Macula at the center of the field. Fundus photo. Topcon TRC-NW8
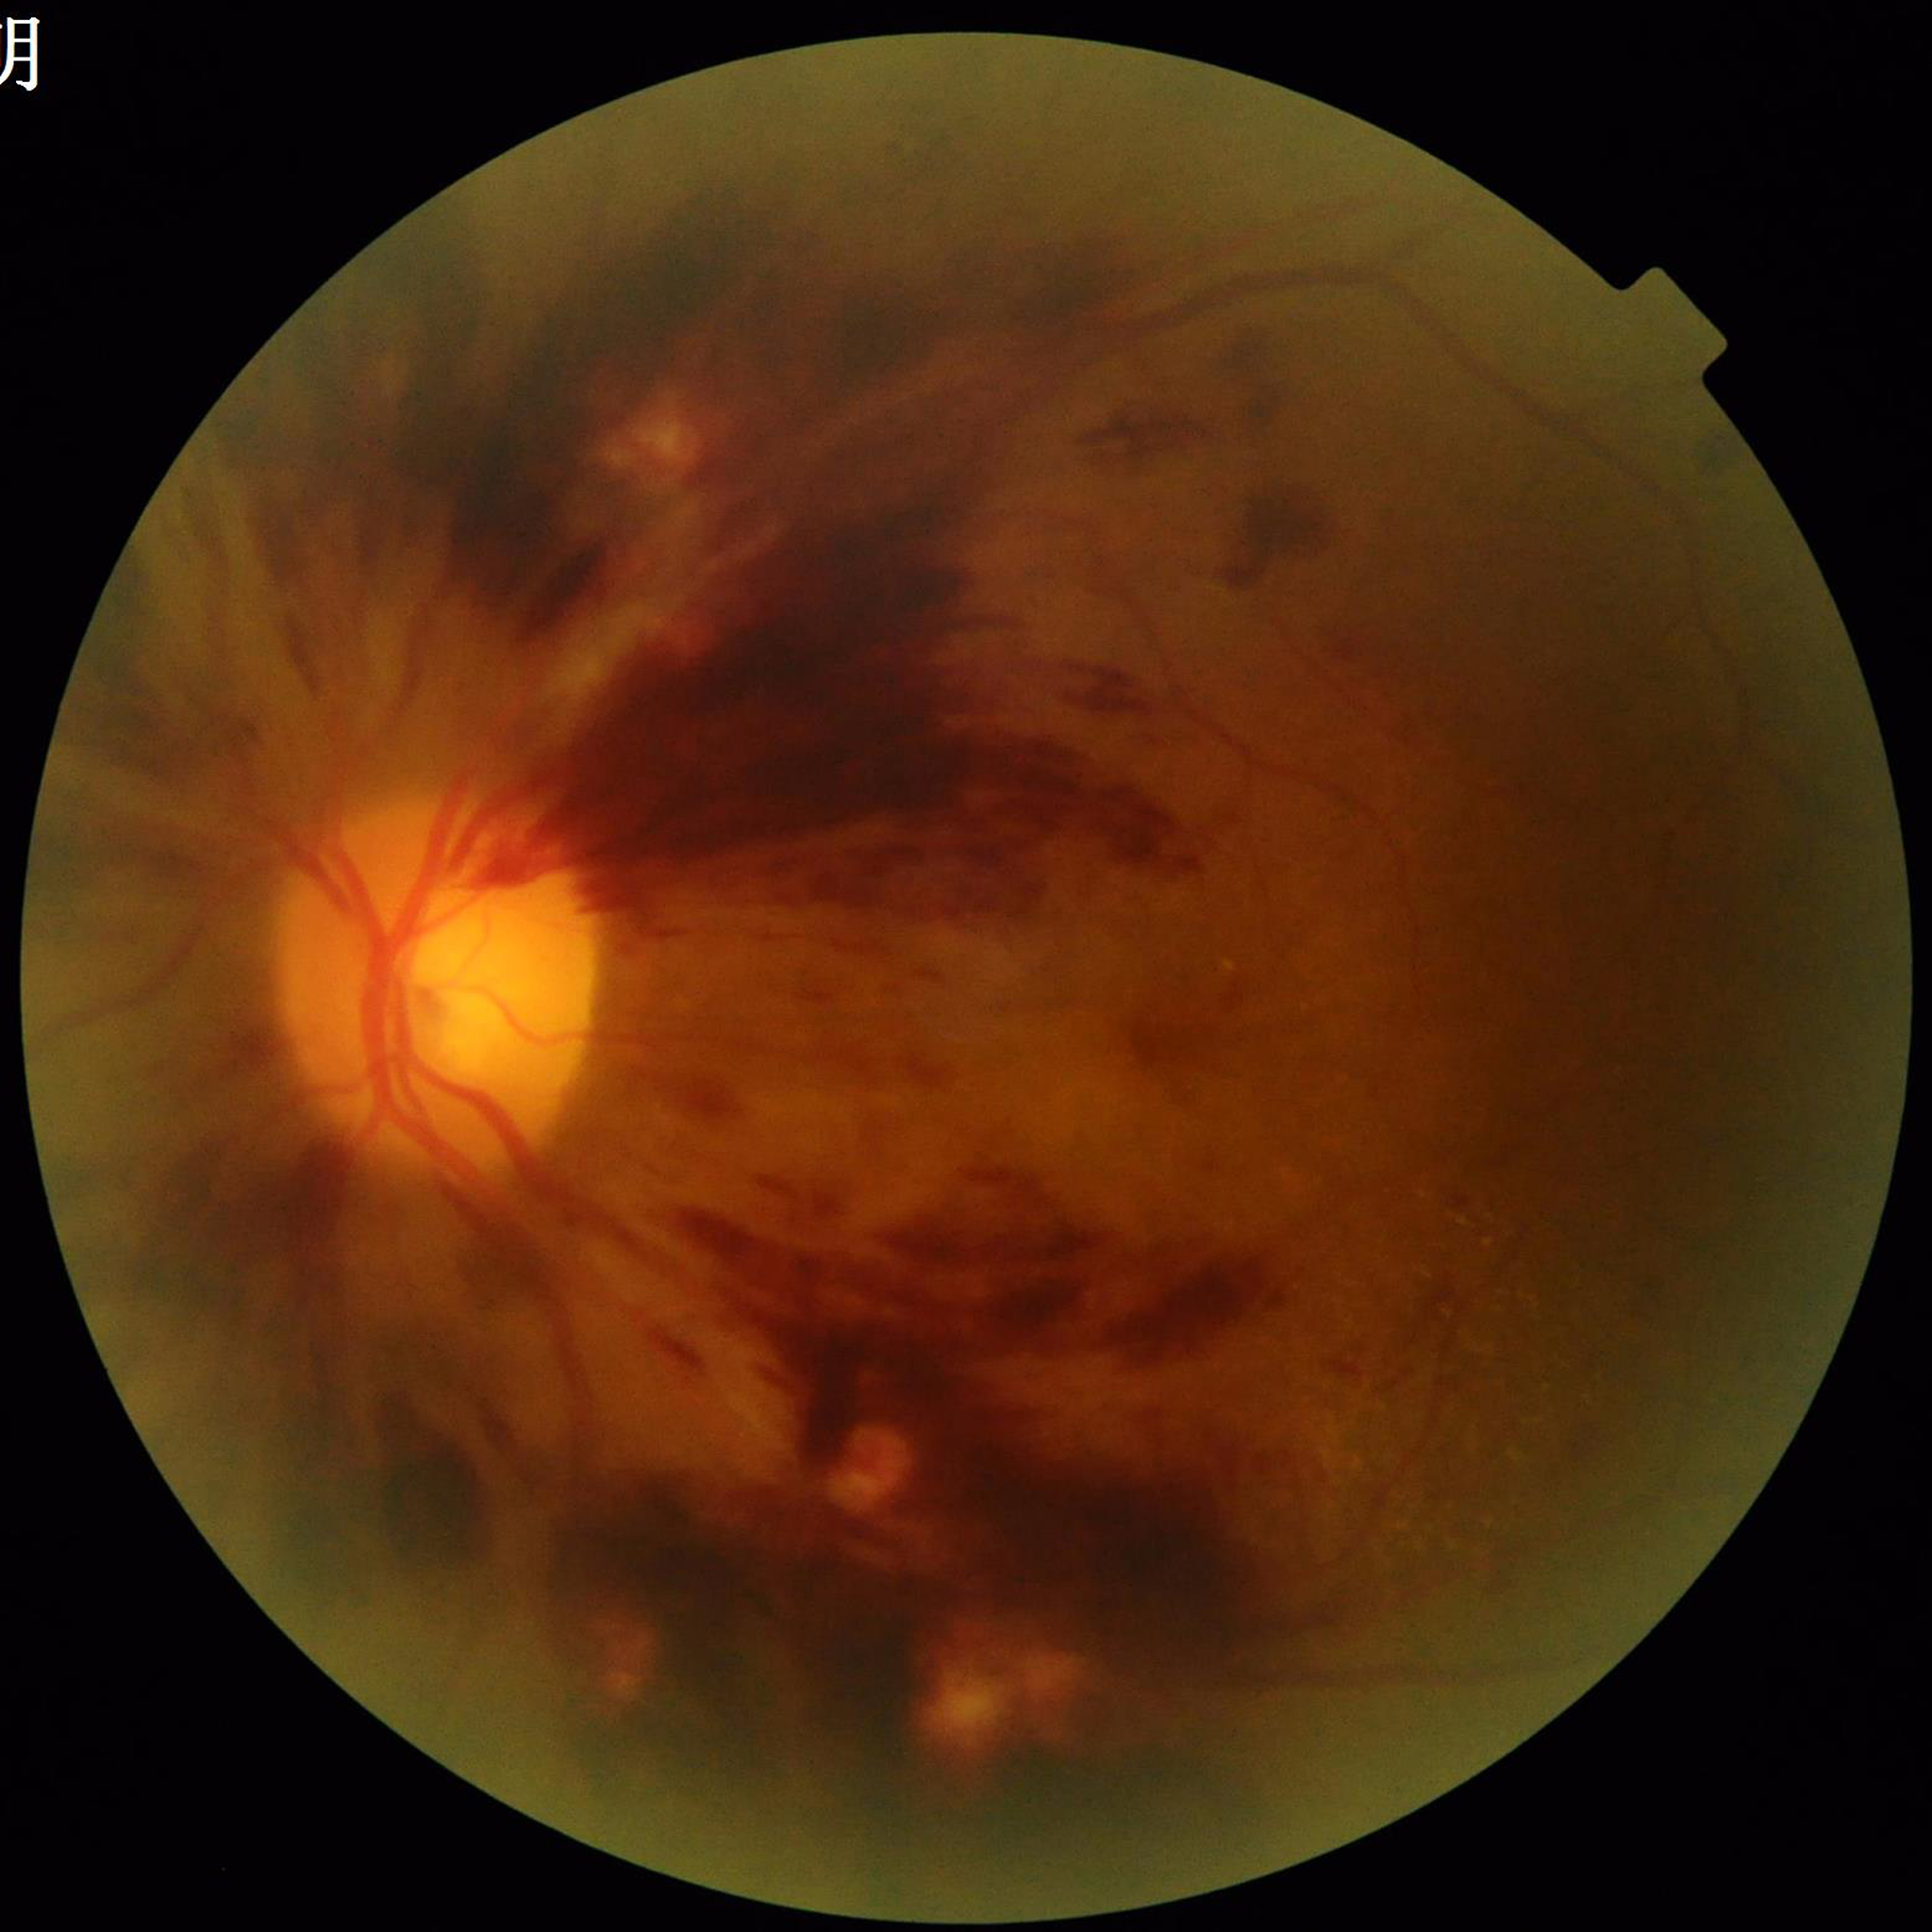
From a patient with diabetic retinopathy. Quality assessment: issues noted — illumination/color distortion, blur.